2361x1568px, 50° FOV, tabletop color fundus camera image
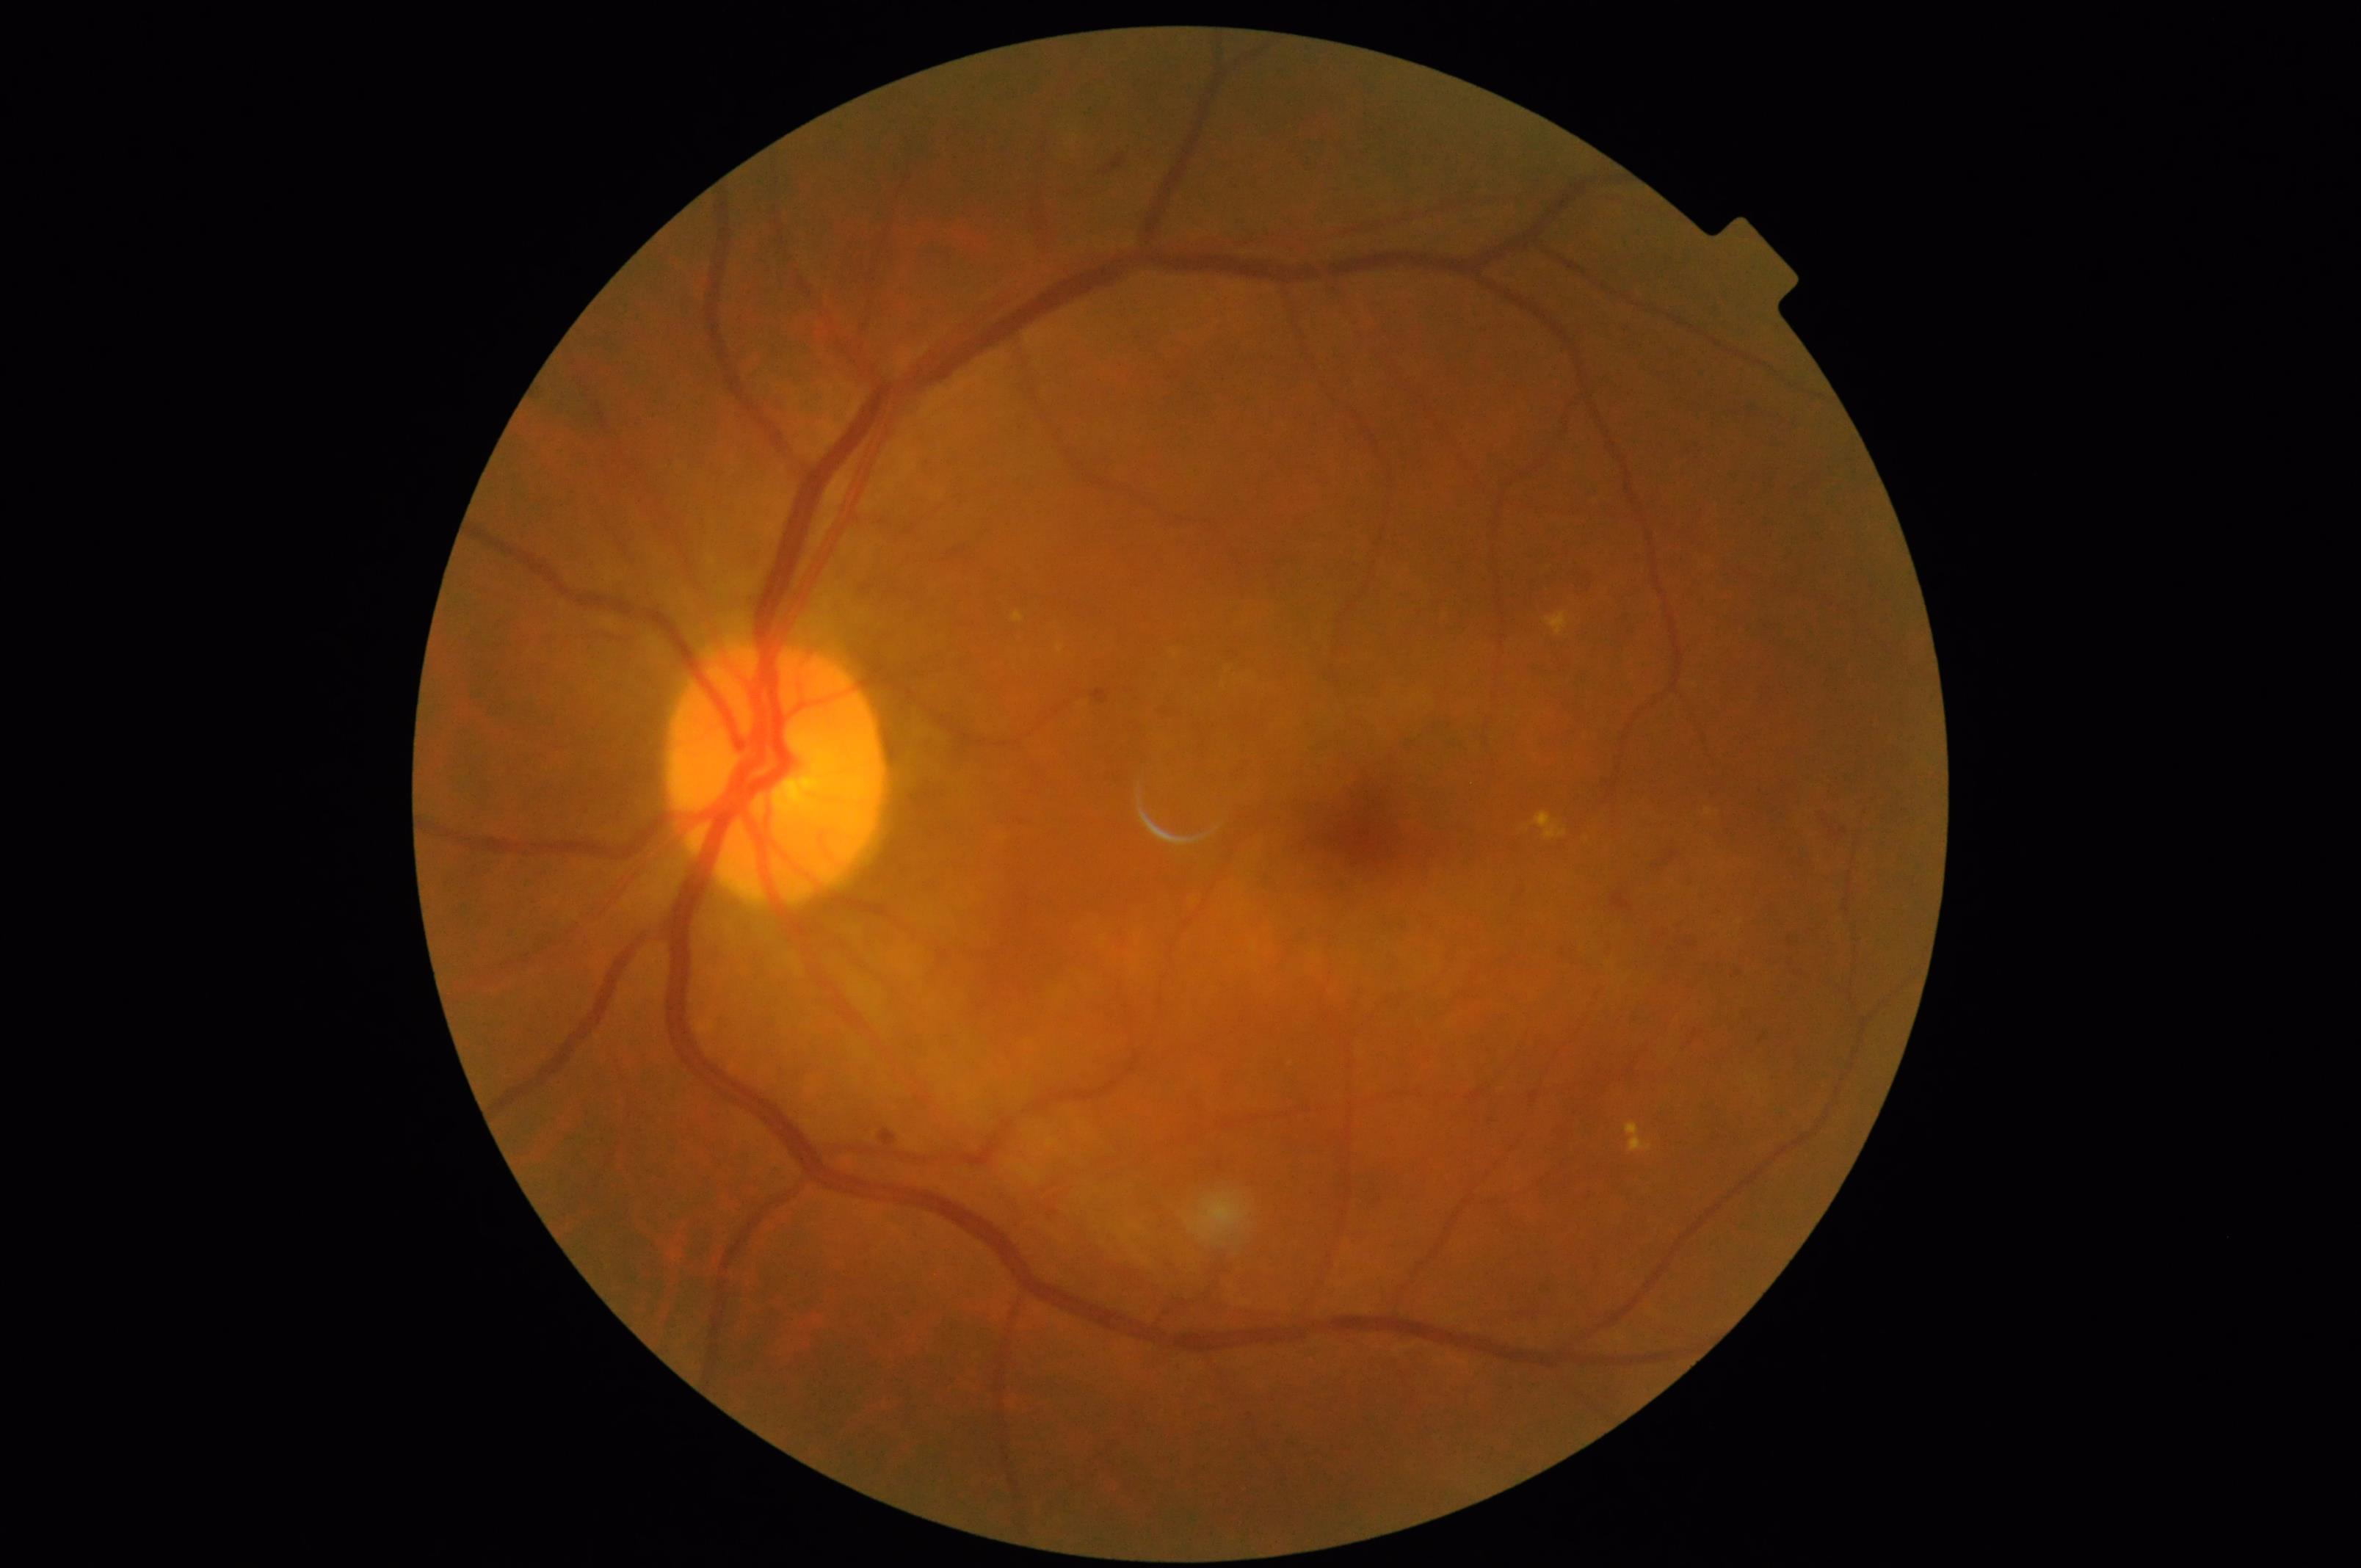

{
  "contrast": "vessels and details readily distinguishable",
  "clarity": "sharp throughout the field",
  "illumination": "uniform, no color cast",
  "overall_quality": "good, gradable"
}